2352 x 1568 pixels — 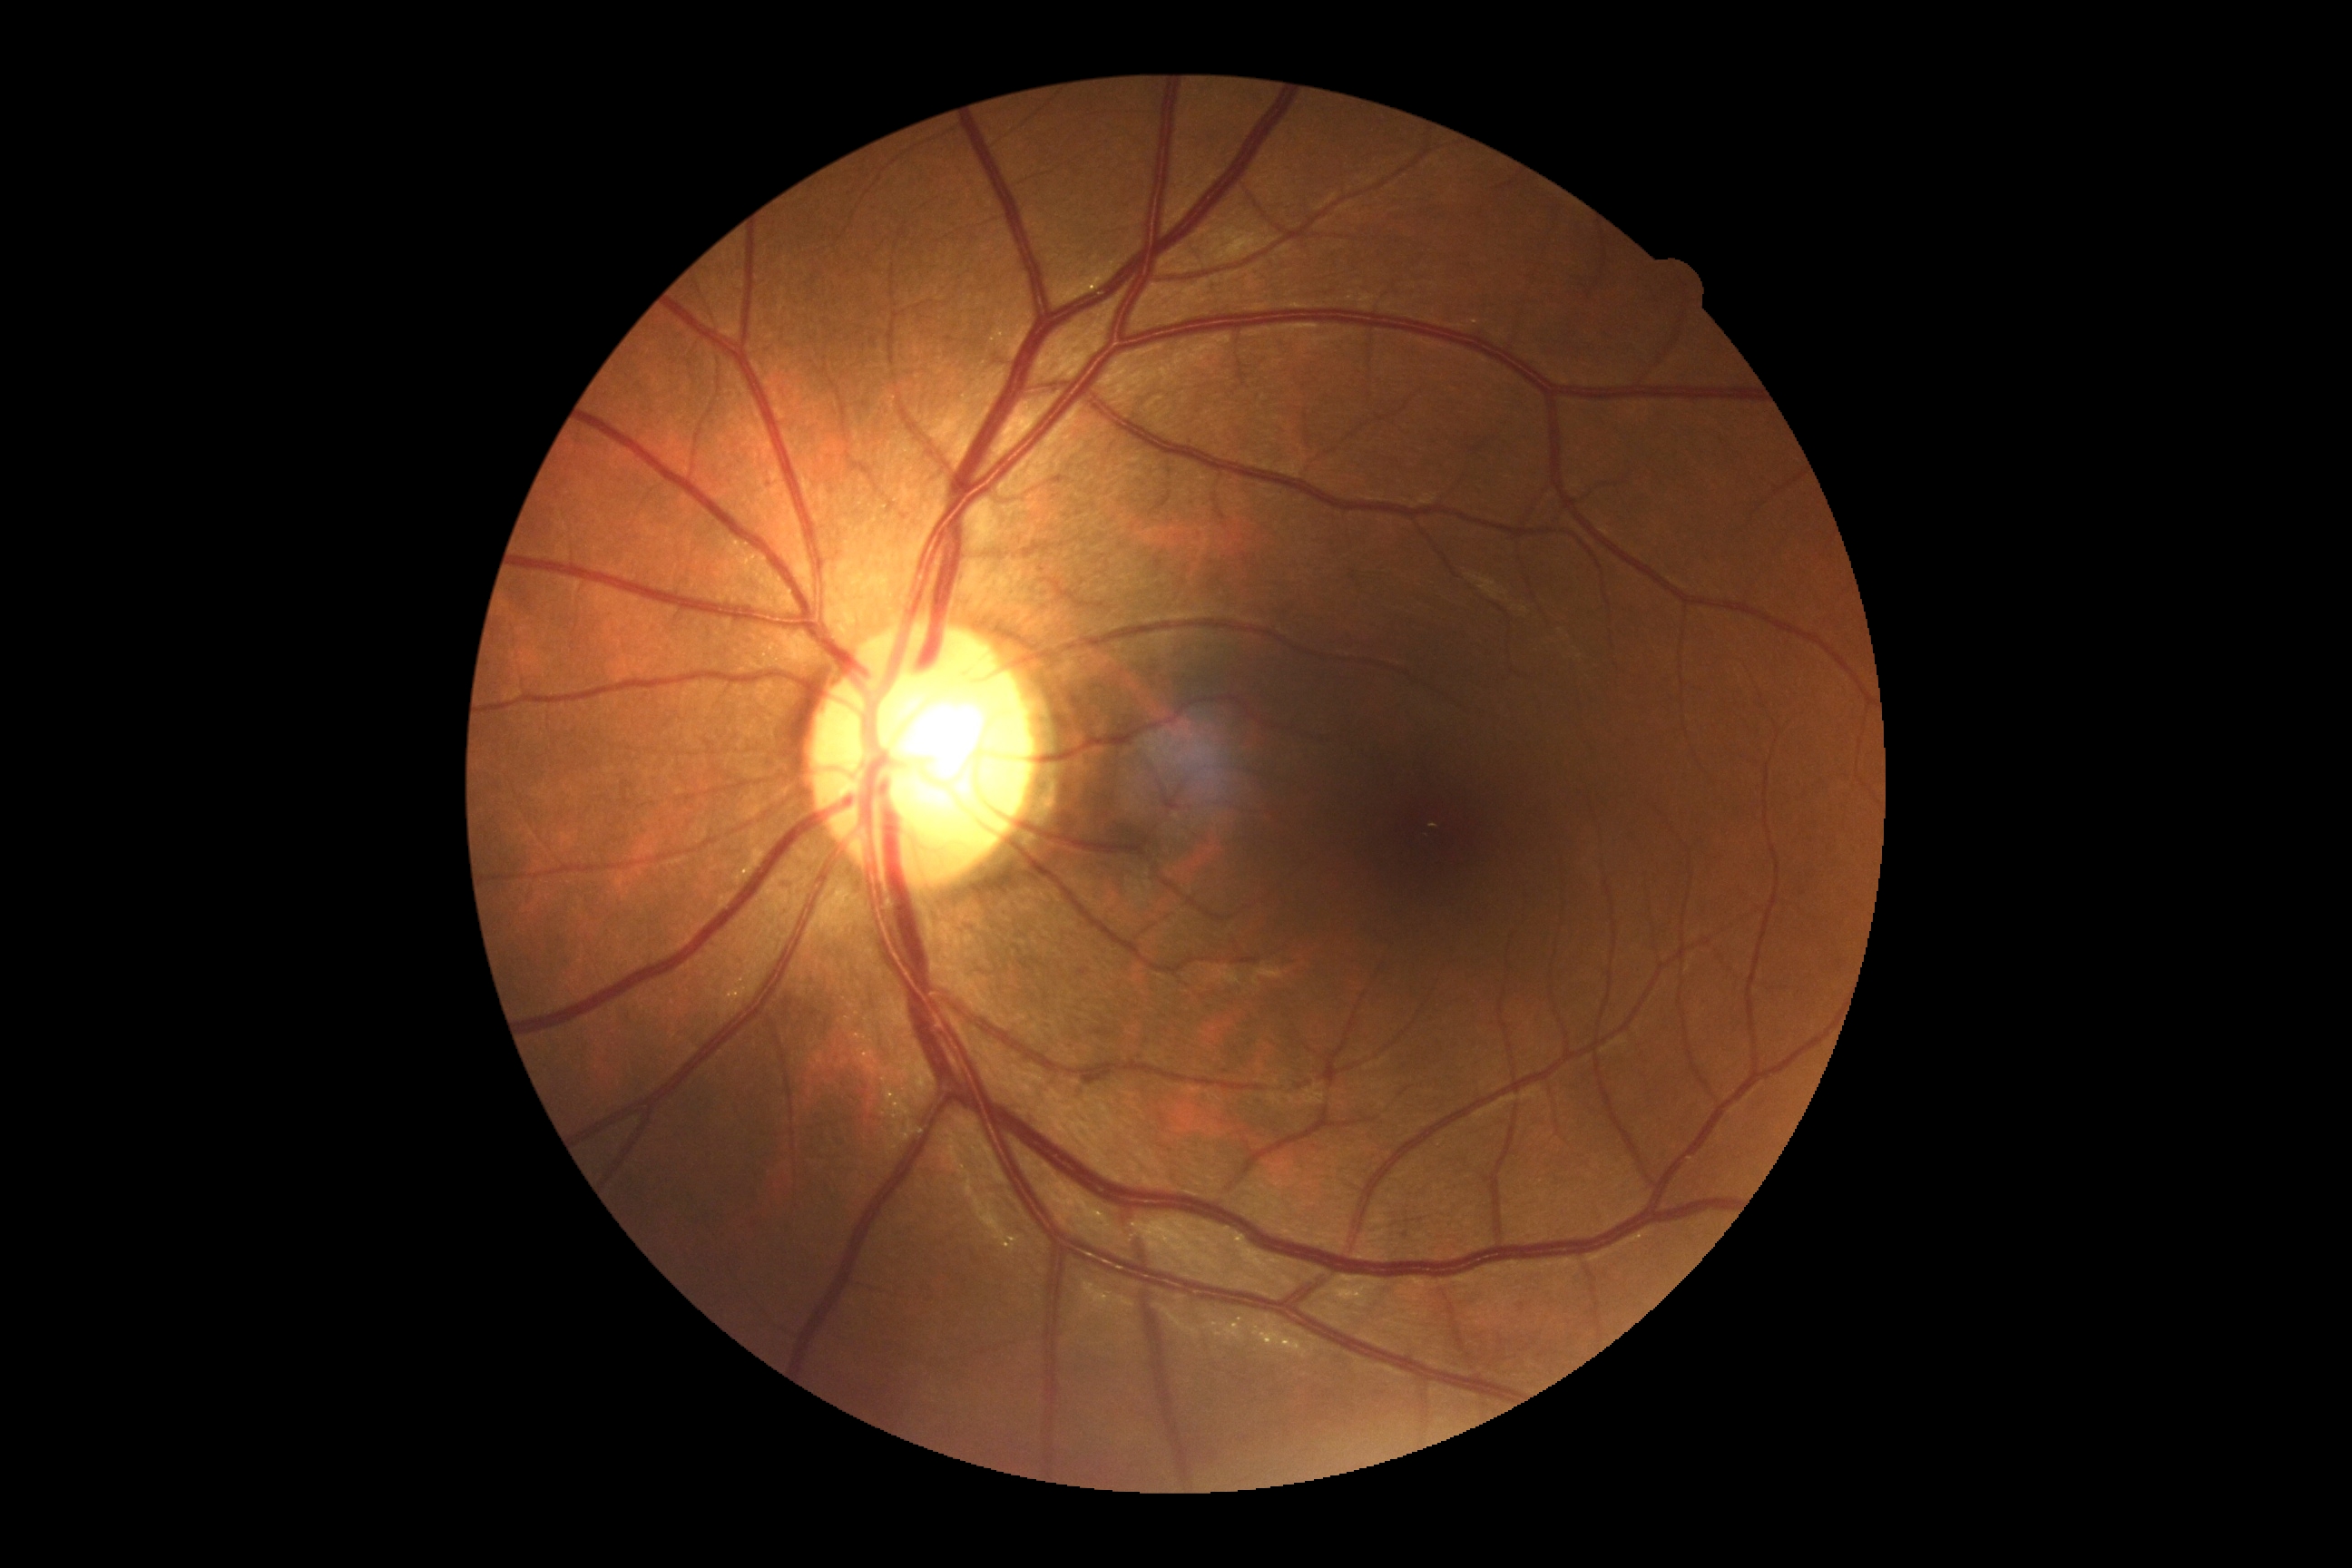 Diabetic retinopathy (DR): grade 0 (no apparent retinopathy). No DR findings.